Image size 1932x1932. Acquired with a Topcon TRC-NW8. FOV: 50 degrees — 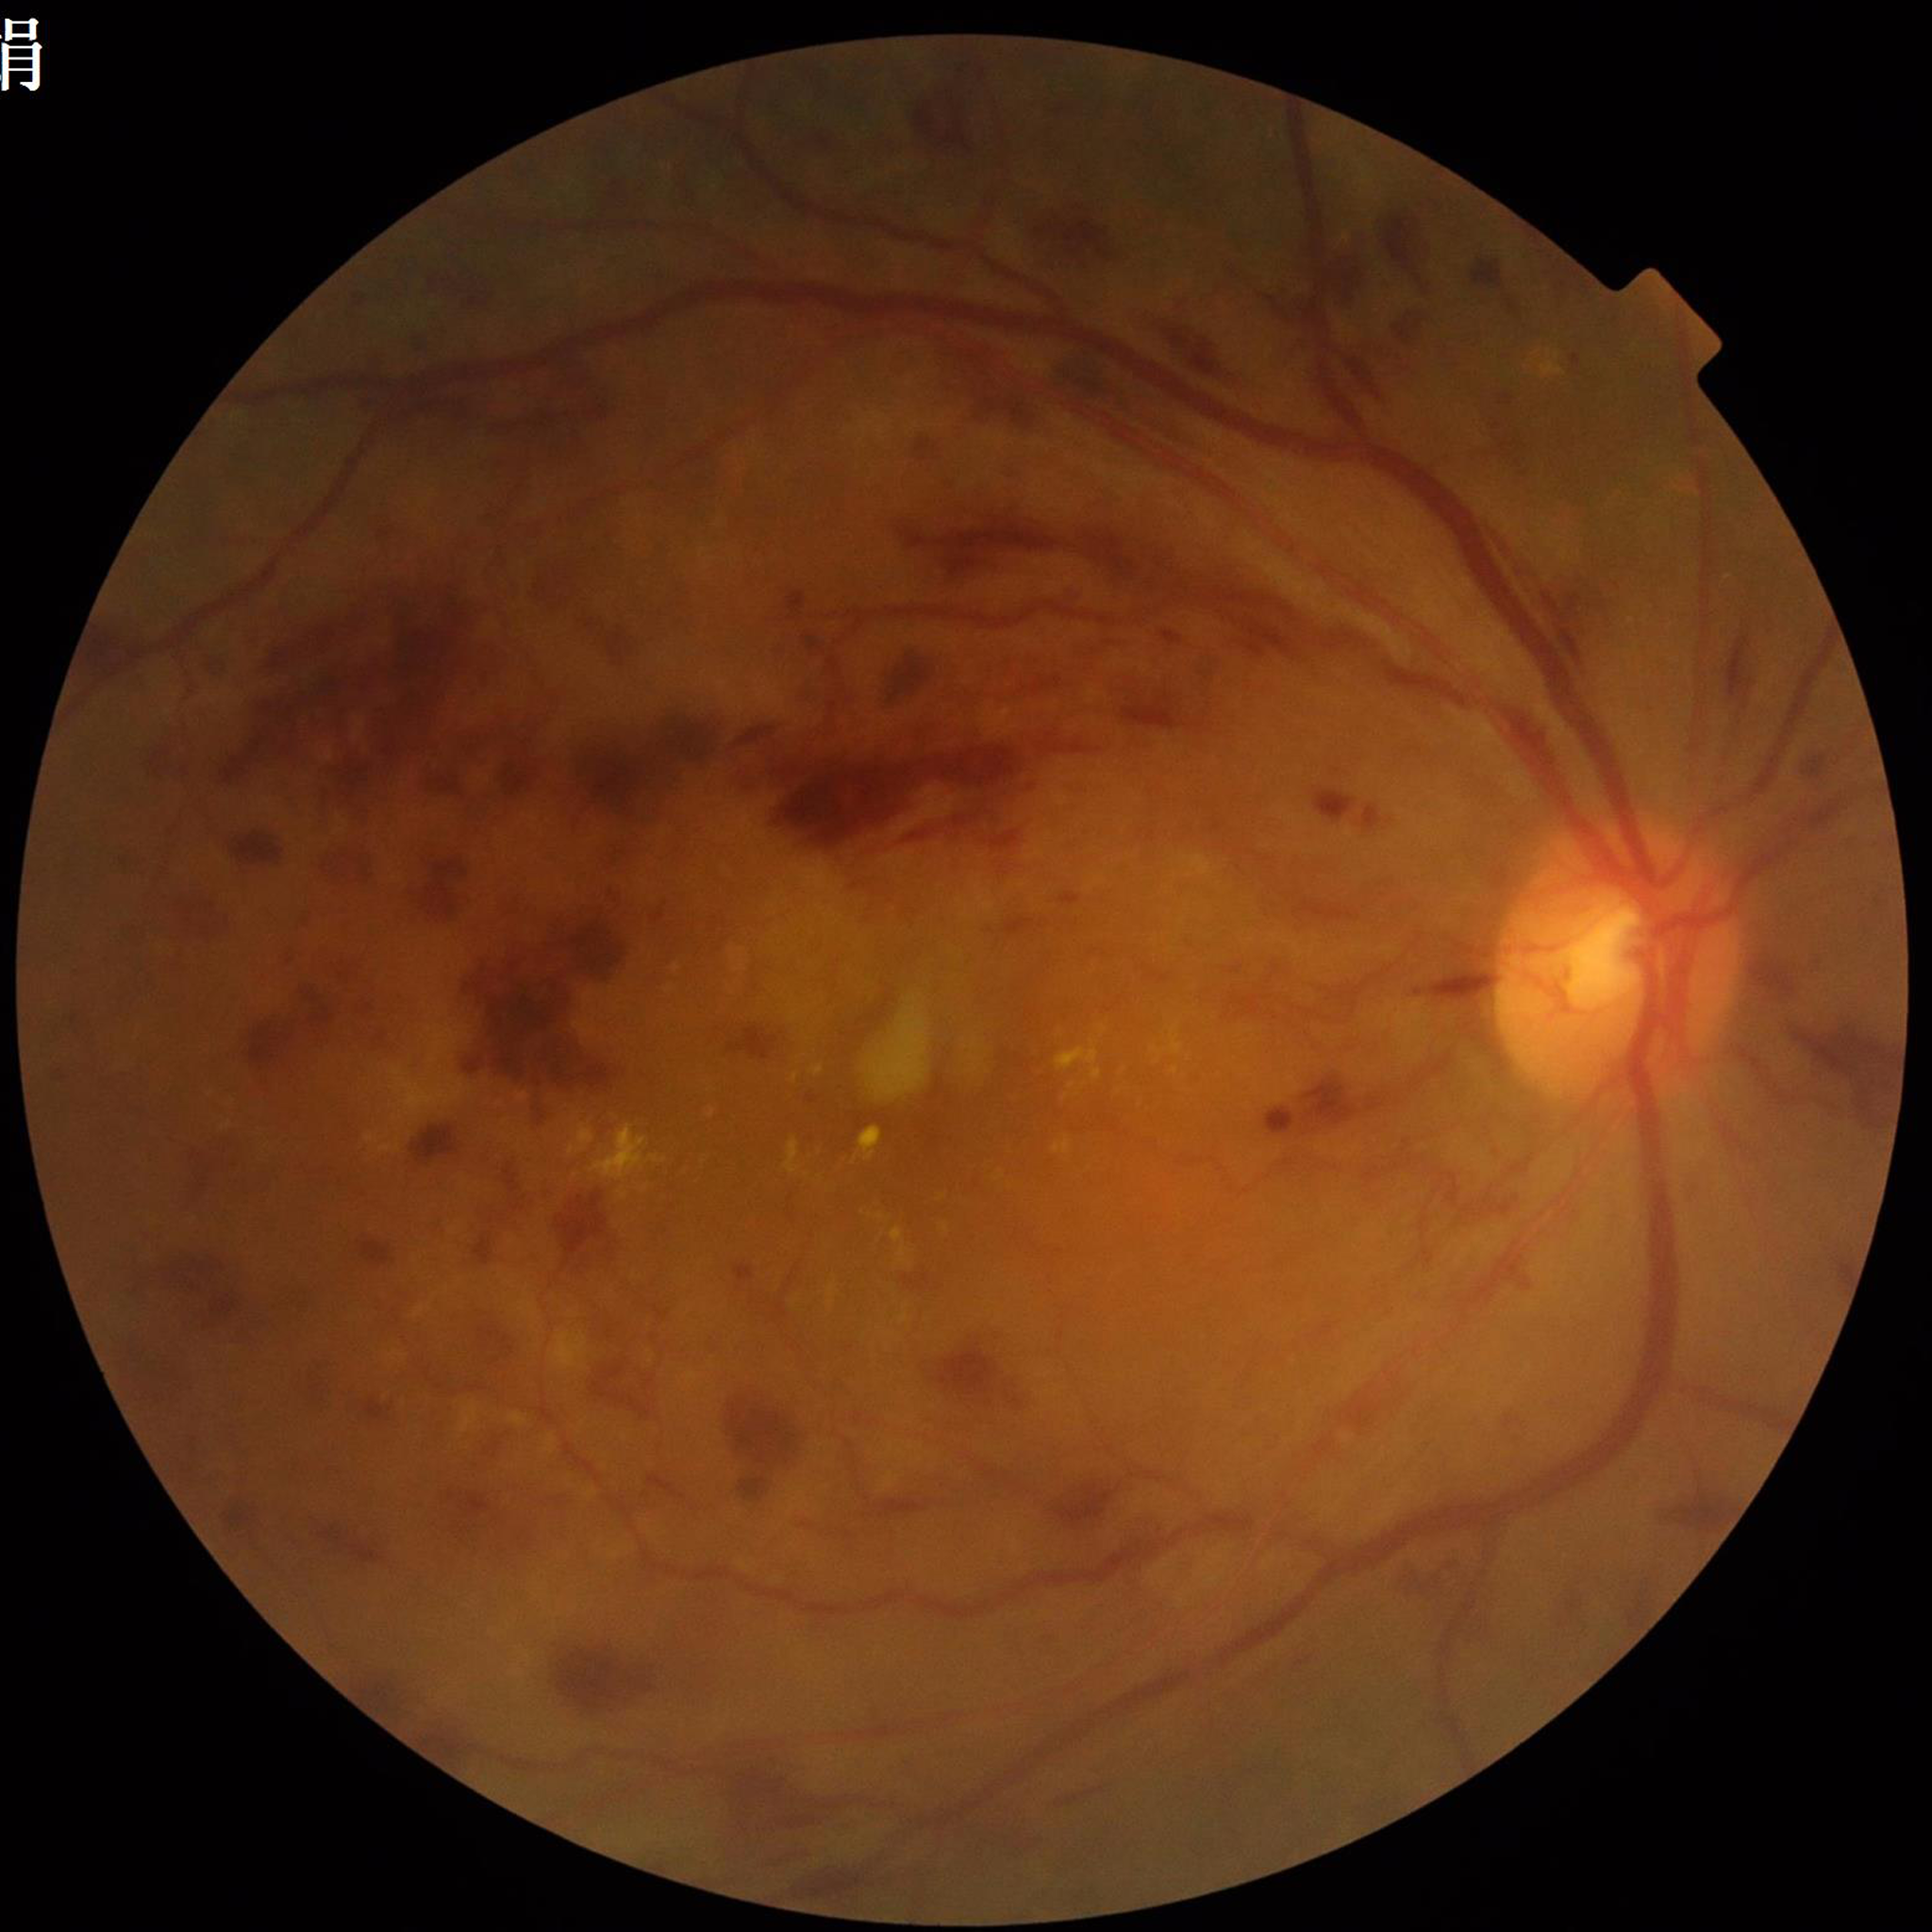

Condition = DR | Quality assessment = no quality issues identified.